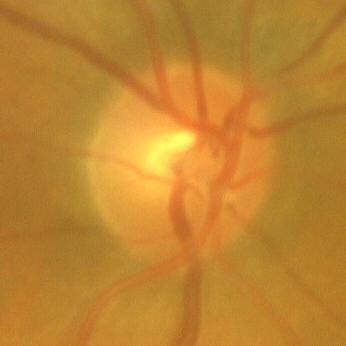

Glaucoma diagnosis: no signs of glaucoma.